1932 by 1916 pixels:
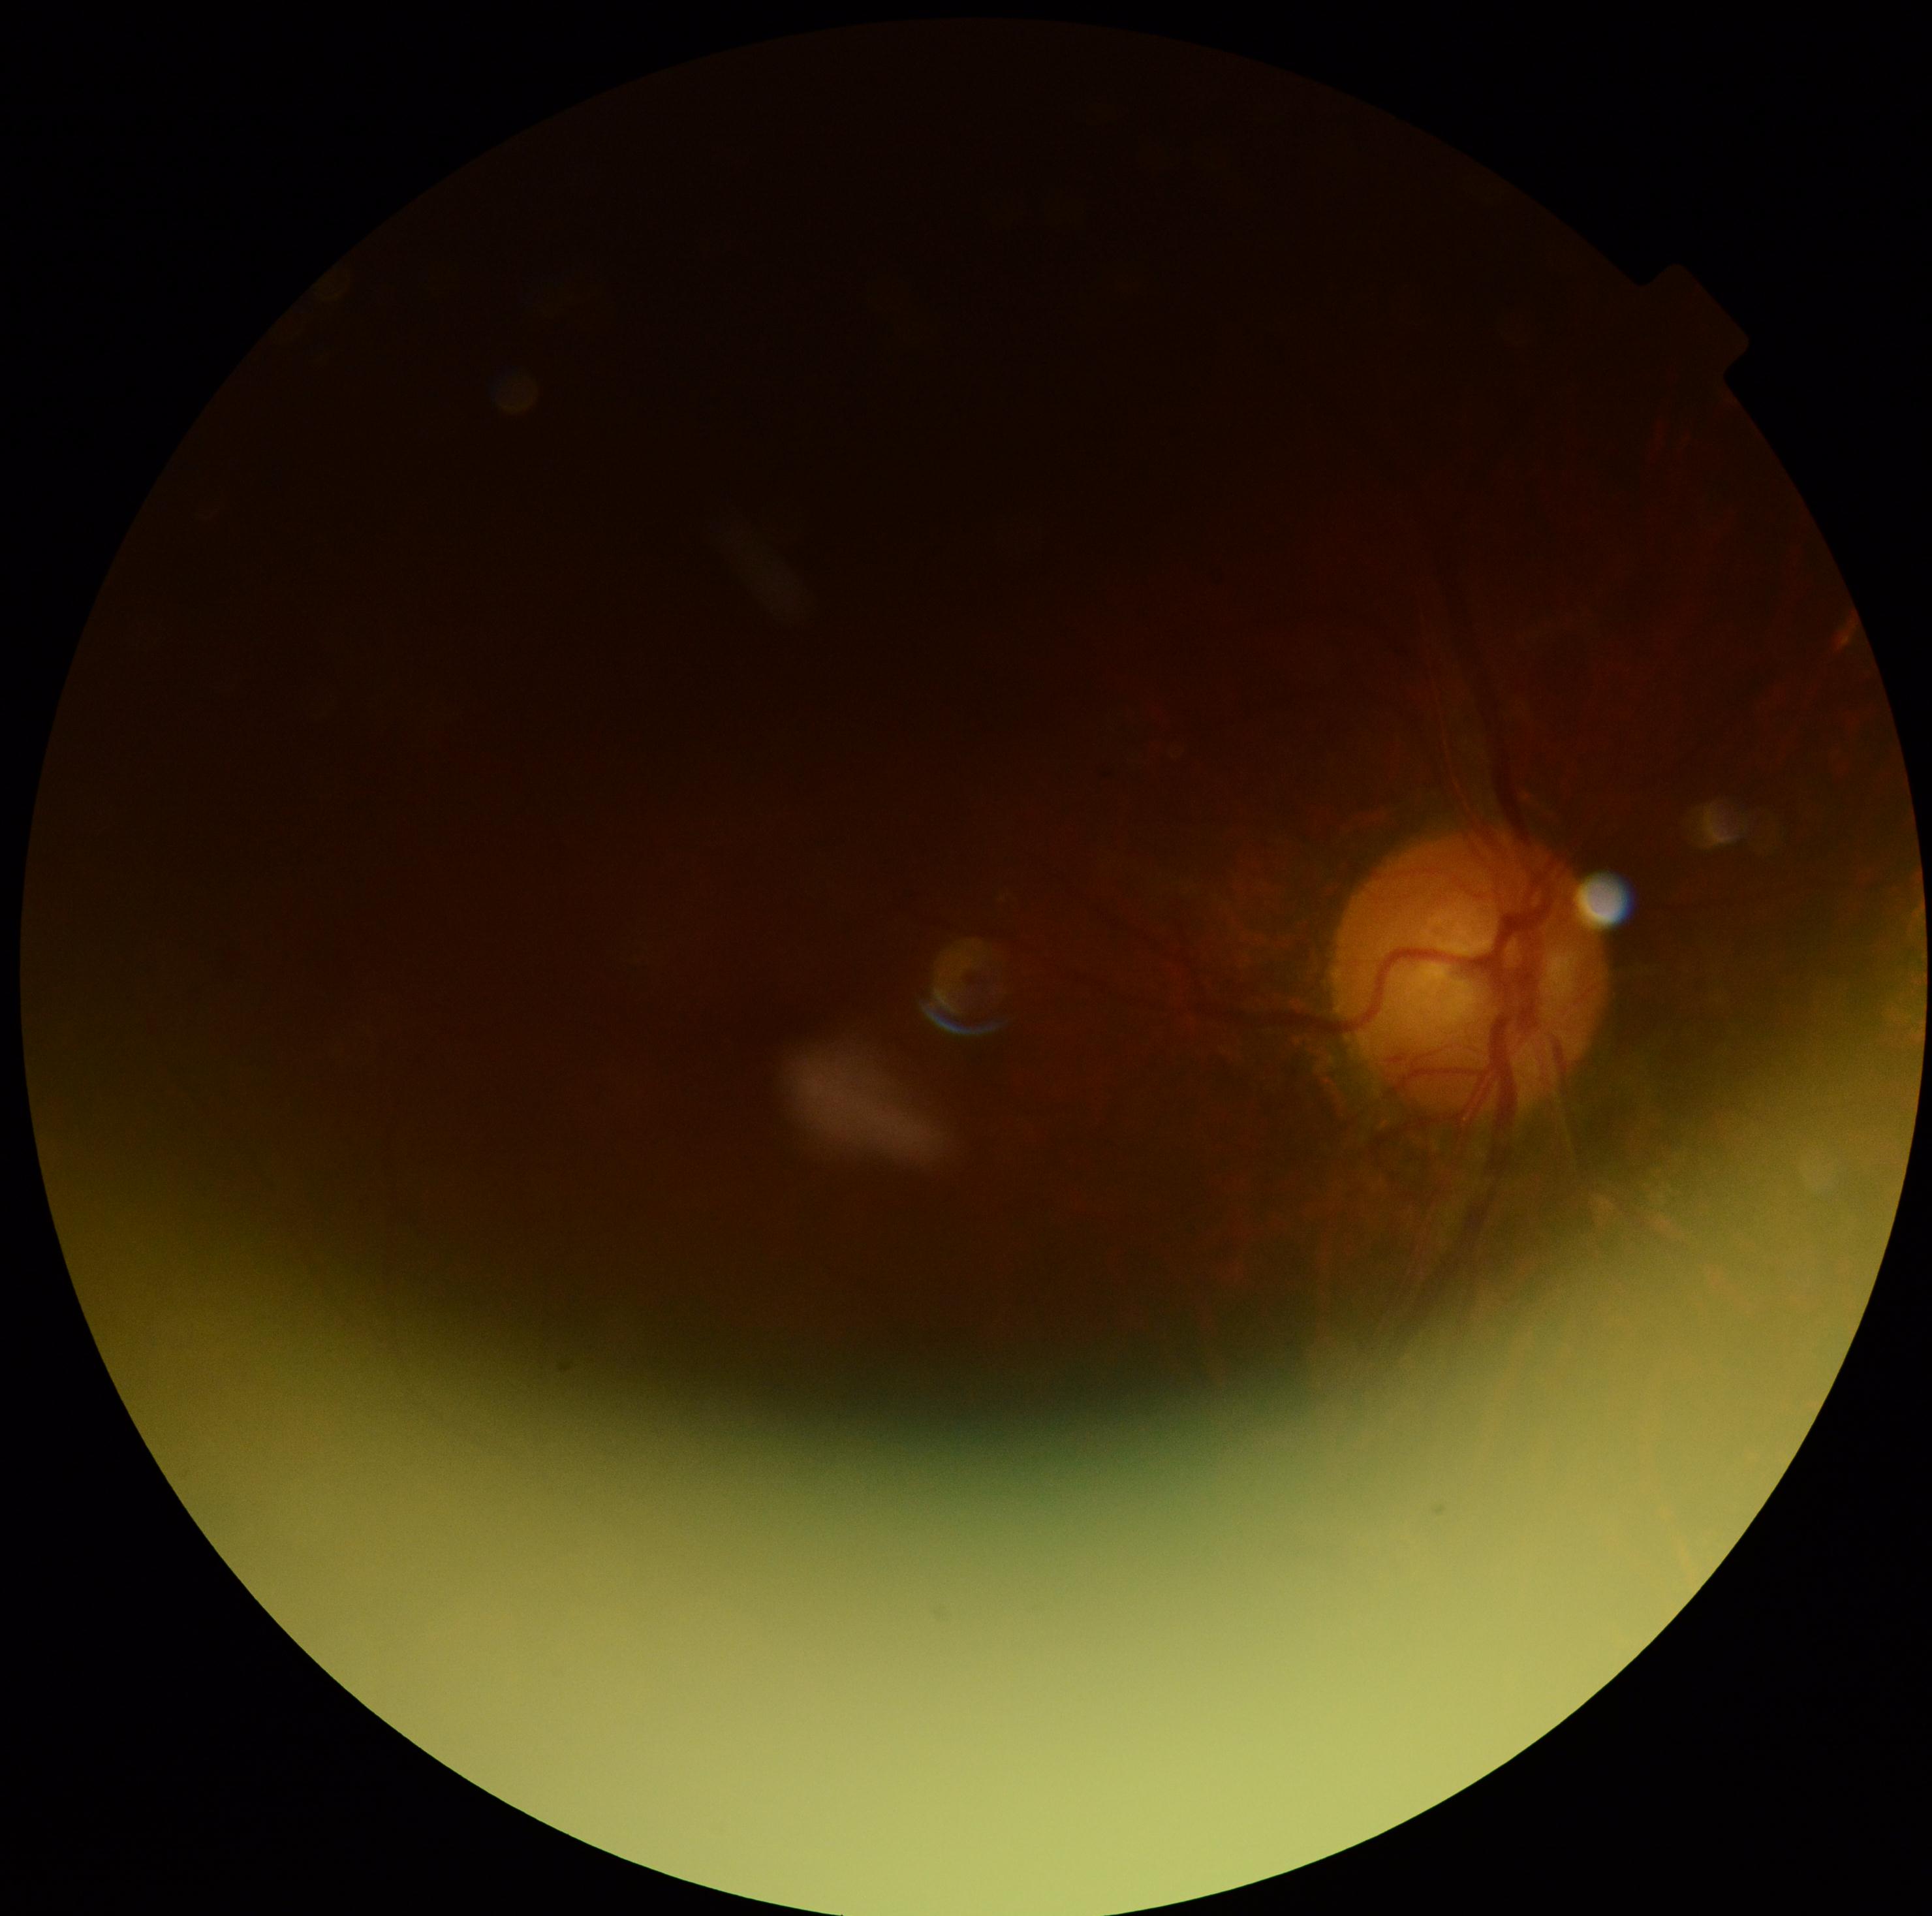
Image quality is insufficient for diabetic retinopathy assessment. DR is ungradable.